130° field of view (Clarity RetCam 3); wide-field fundus photograph from neonatal ROP screening:
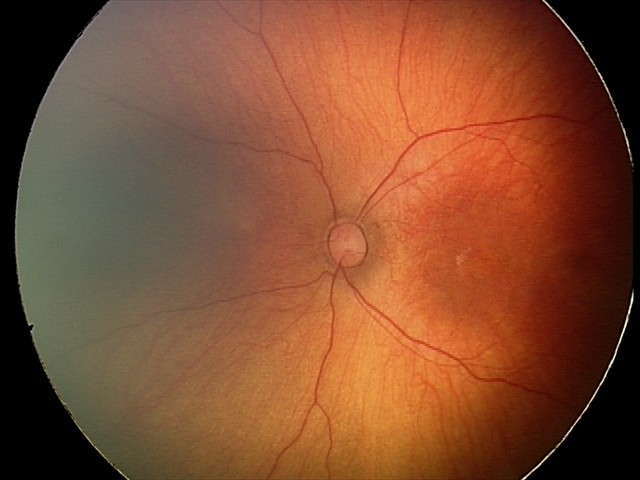
Screening examination diagnosed as physiological.